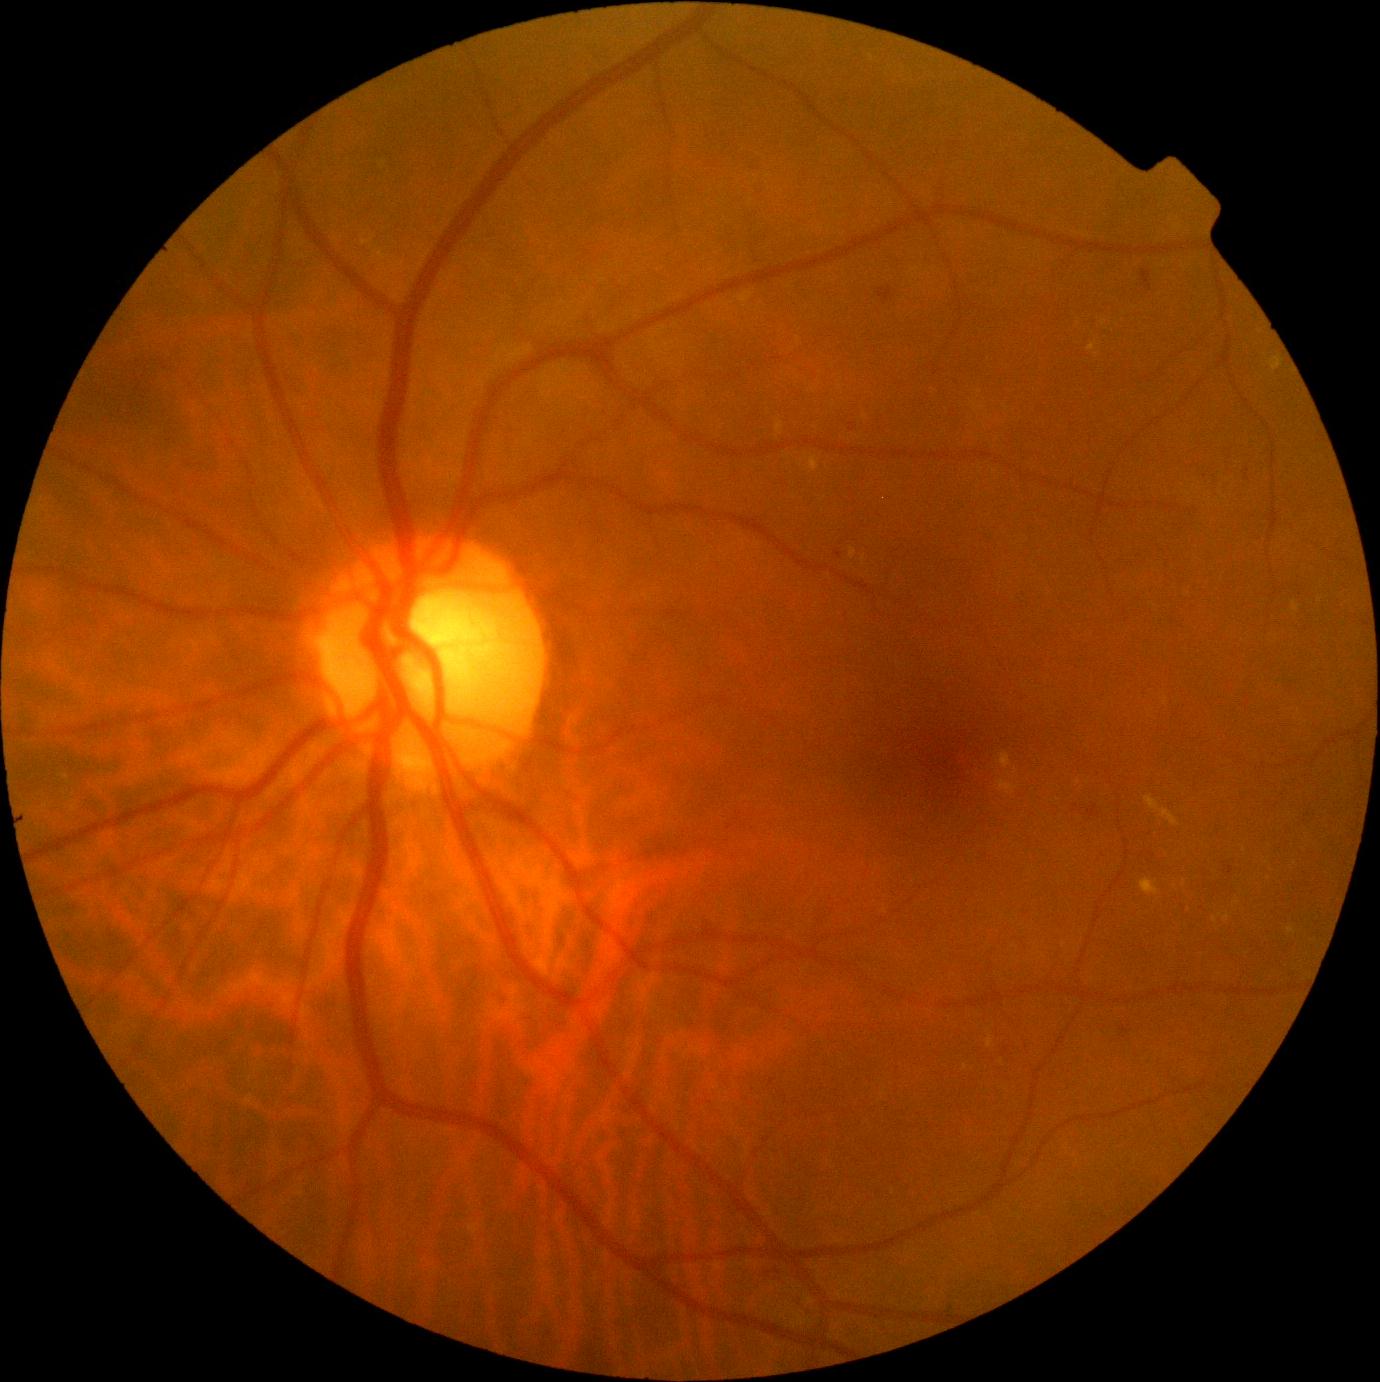
Diabetic retinopathy severity is grade 2 (moderate NPDR)
A subset of detected lesions:
hemorrhages: 1088:806:1097:818
Small hemorrhages approximately at x=1076, y=806
hard exudates (more not shown): 1088:343:1097:352; 1287:928:1296:935; 1144:795:1179:827; 808:456:820:472; 999:780:1018:795; 739:293:752:304; 849:547:857:559
Small hard exudates approximately at x=1105, y=323; x=1245, y=851; x=1184, y=883; x=966, y=1067; x=1010, y=774; x=1016, y=770; x=1166, y=701; x=1269, y=878; x=66, y=777
microaneurysms: 1142:270:1152:291; 835:551:843:559; 878:287:894:302; 1225:866:1235:874; 849:423:856:433; 1121:1026:1130:1033
Small microaneurysms approximately at x=1152, y=855
soft exudates: none detected